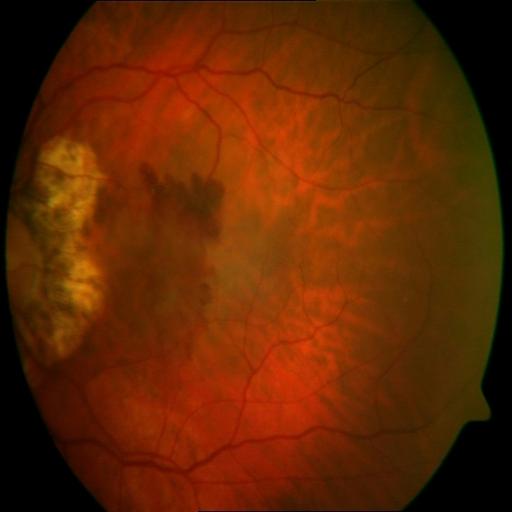 Findings (2): myopia, tessellation.